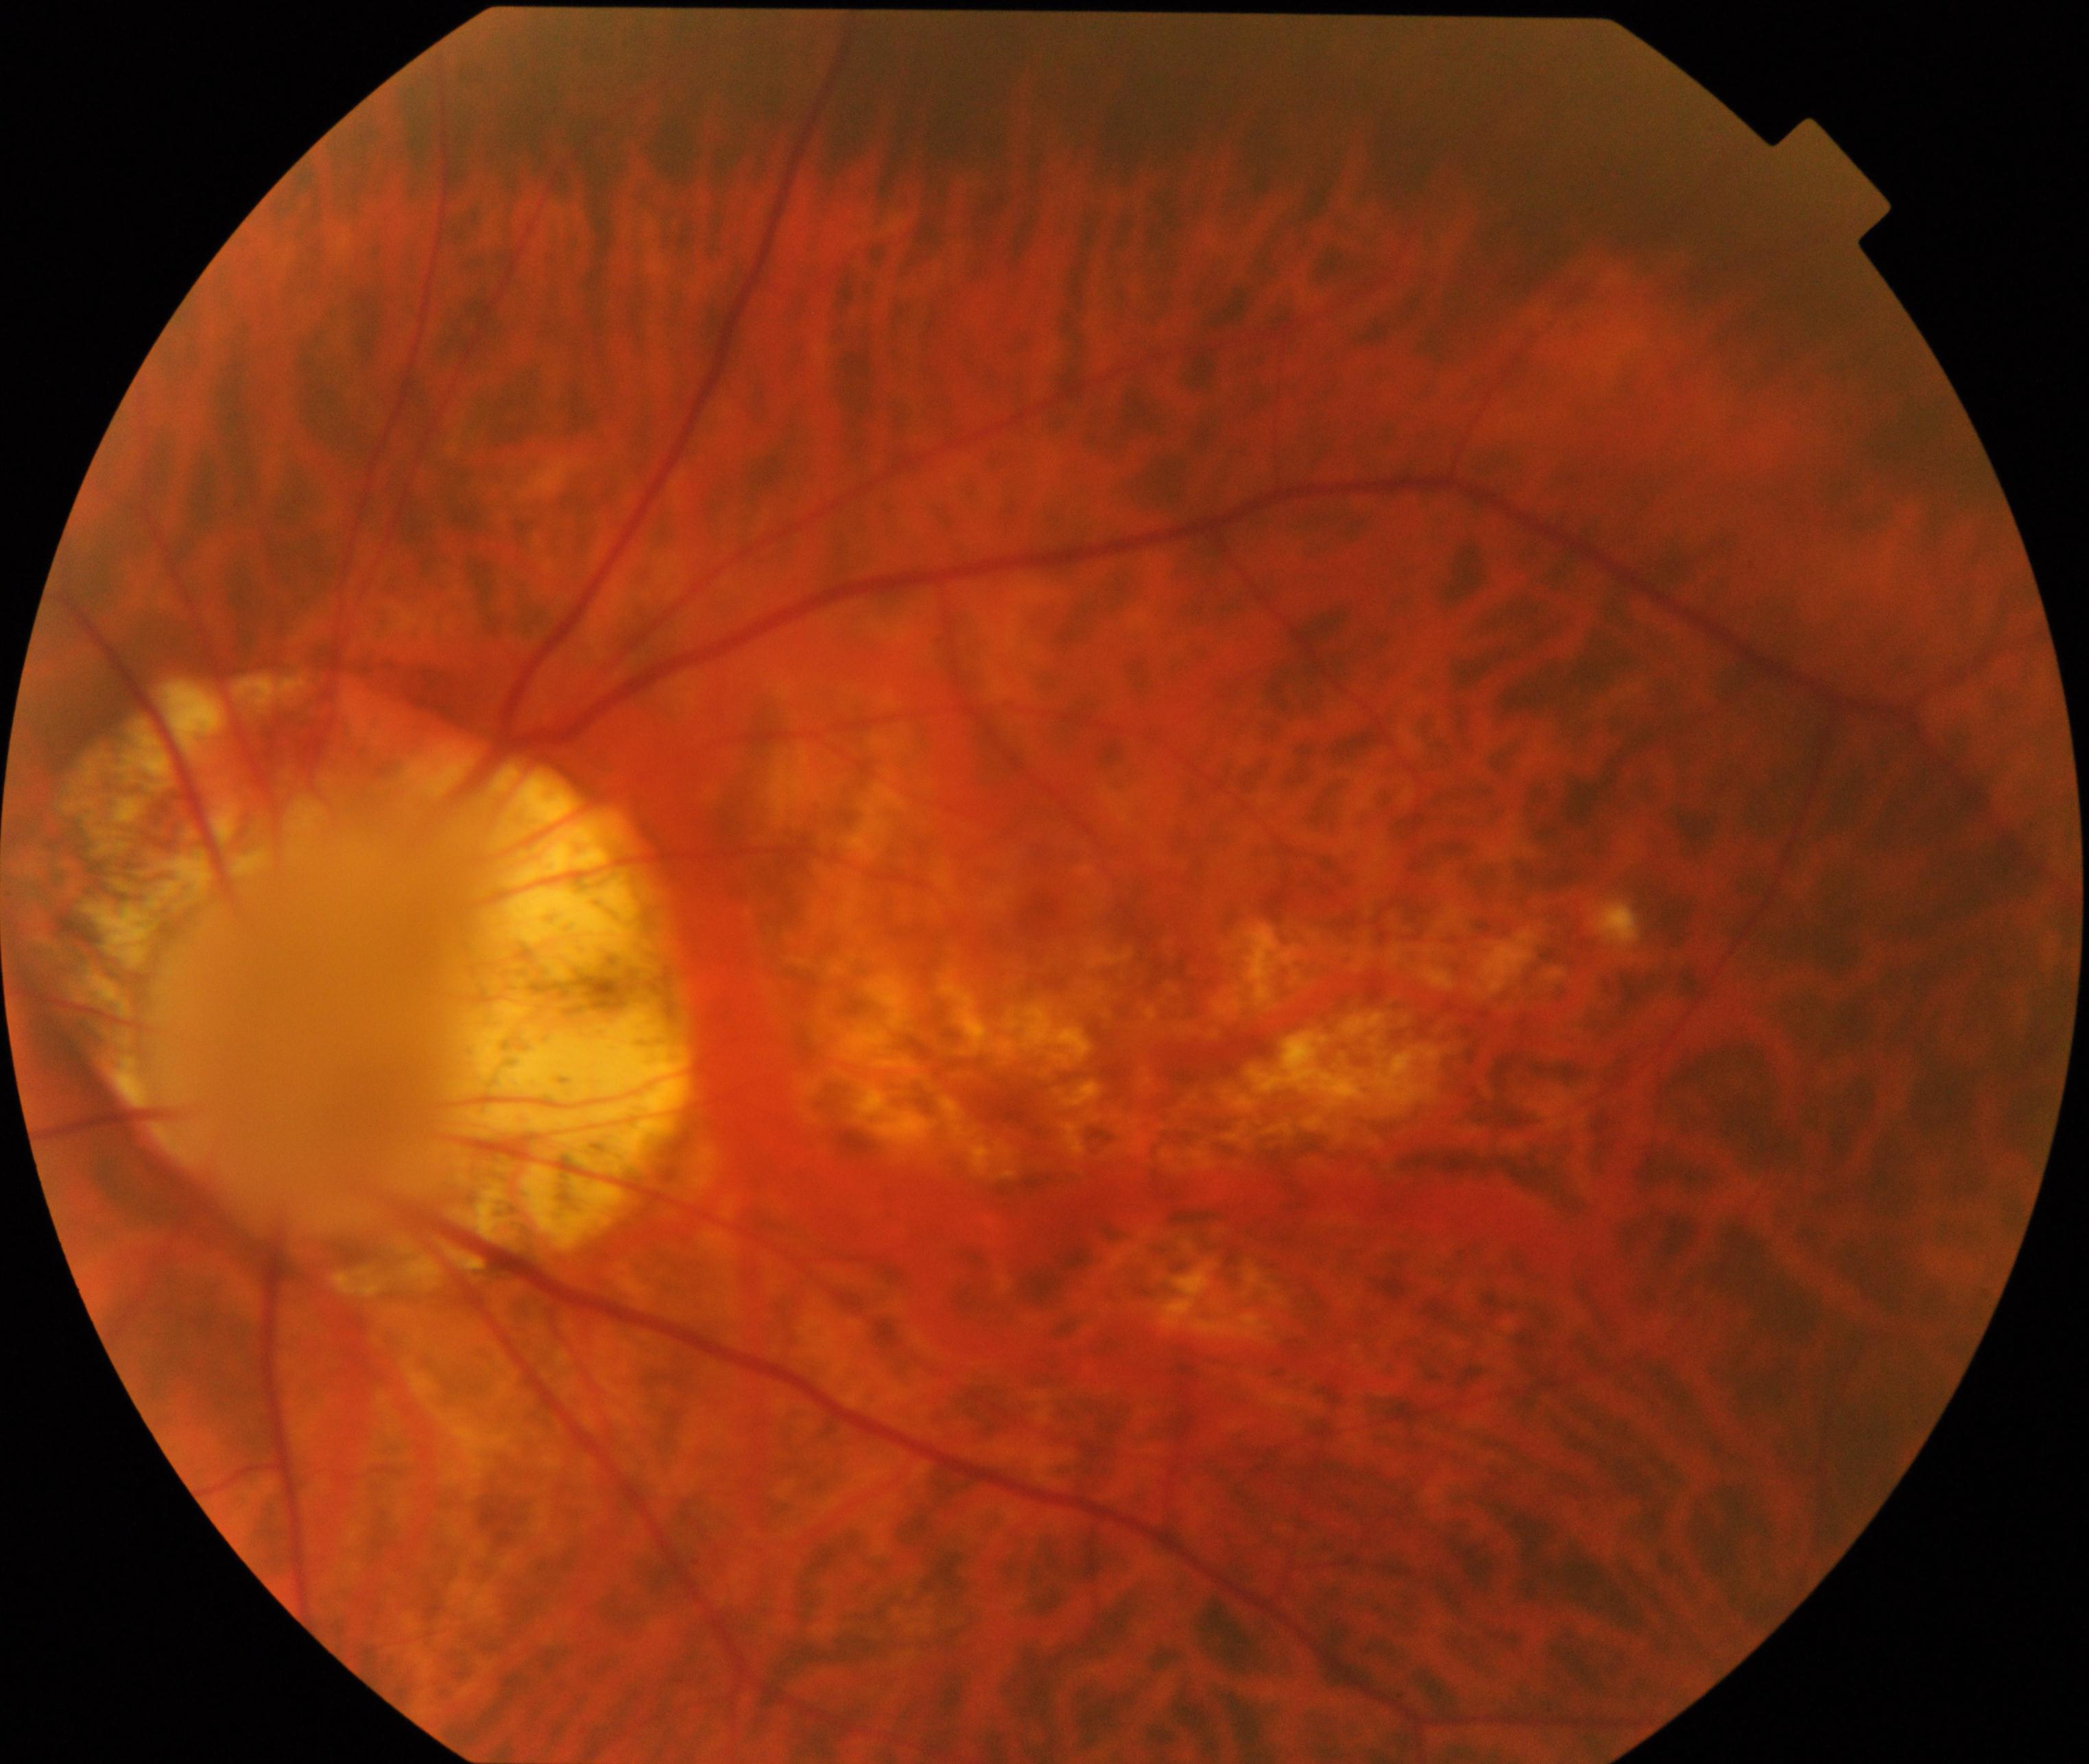

There is evidence of pathological myopia. Features include tessellated fundus with focal chorioretinal atrophy, Fuchs spot, lacquer cracks, choroidal neovascularization, or subretinal hemorrhage.